1924 by 1556 pixels, ultra-widefield fundus mosaic: 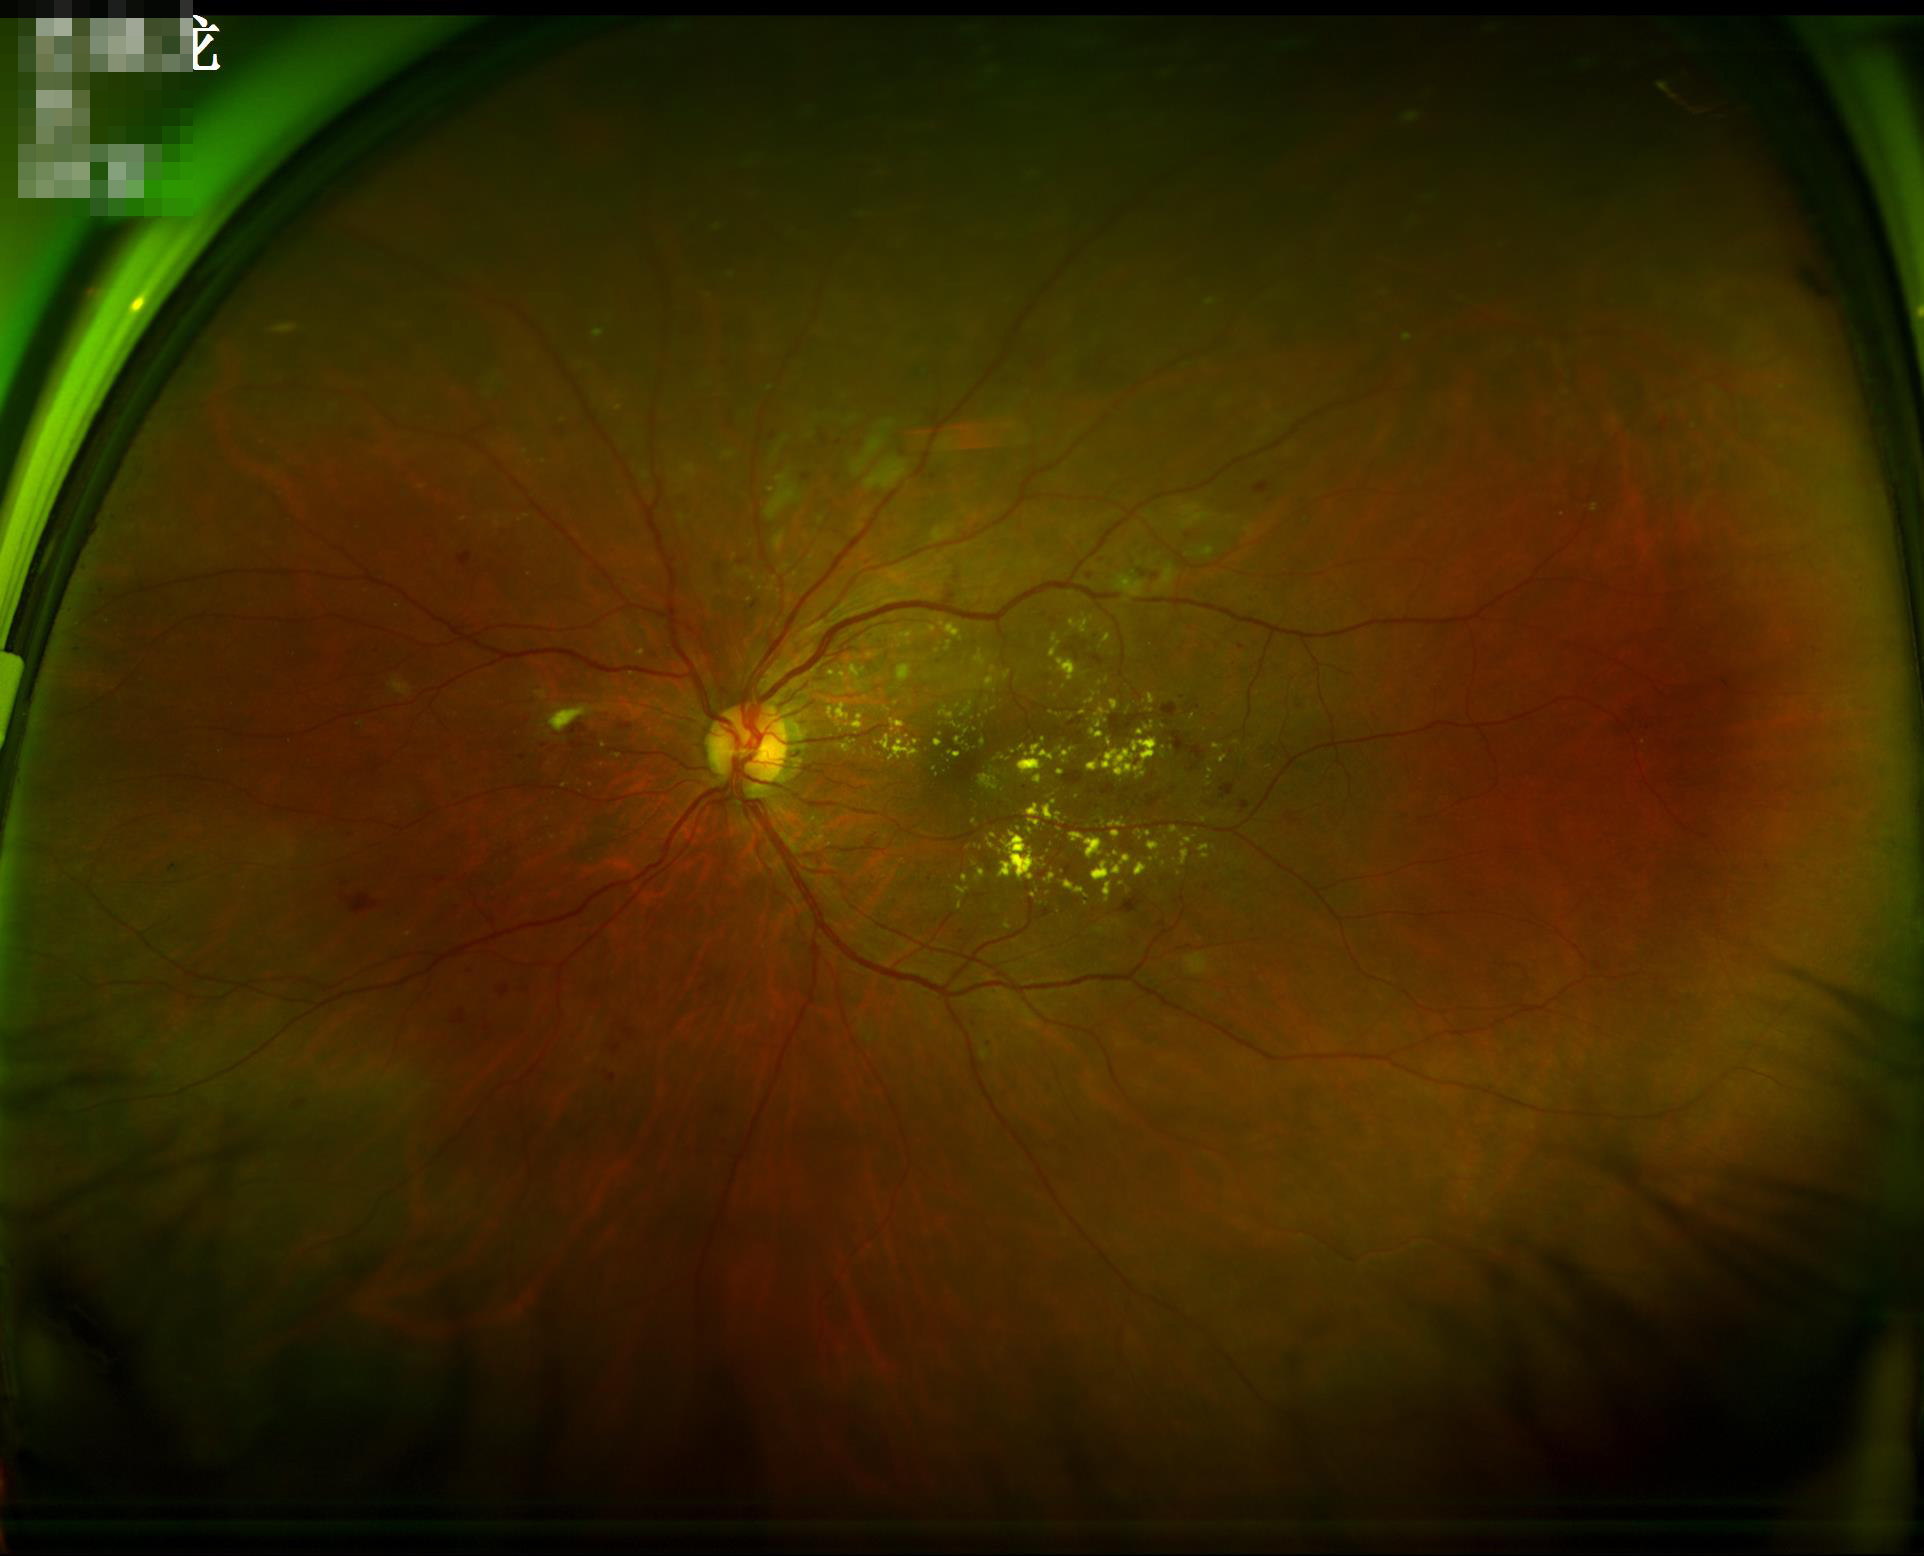 Image quality assessment: contrast: satisfactory | illumination/color: even | overall: satisfactory | sharpness: in focus.